Modified Davis classification: 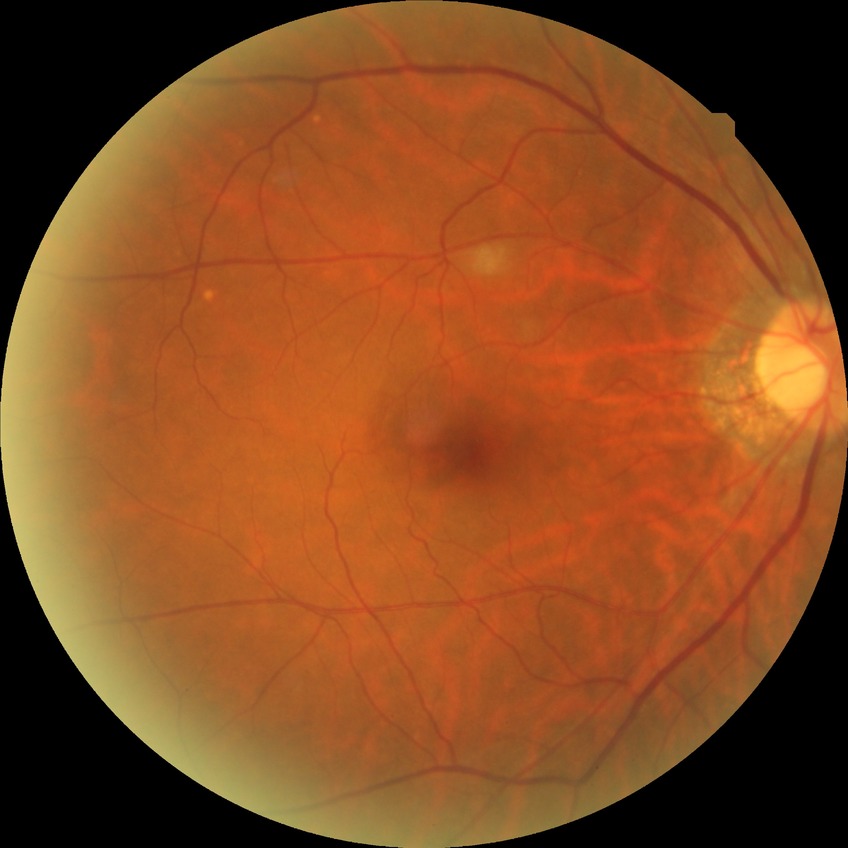 DR: NDR | DR impression: negative for DR.